130° field of view (Clarity RetCam 3). Image size 640x480. Wide-field fundus photograph from neonatal ROP screening.
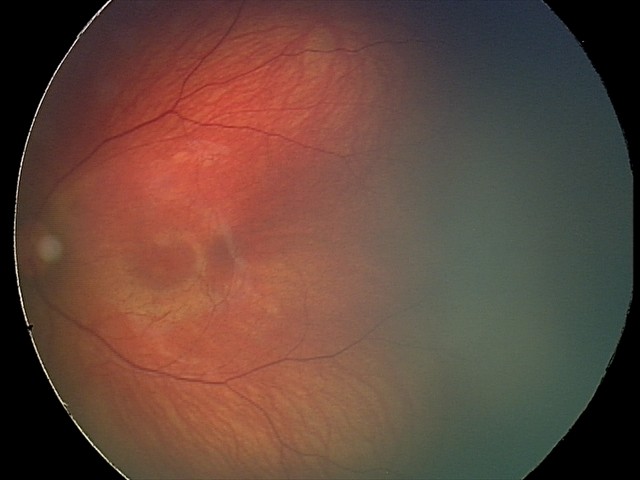 Screening series with retinal hemorrhages.